45-degree field of view.
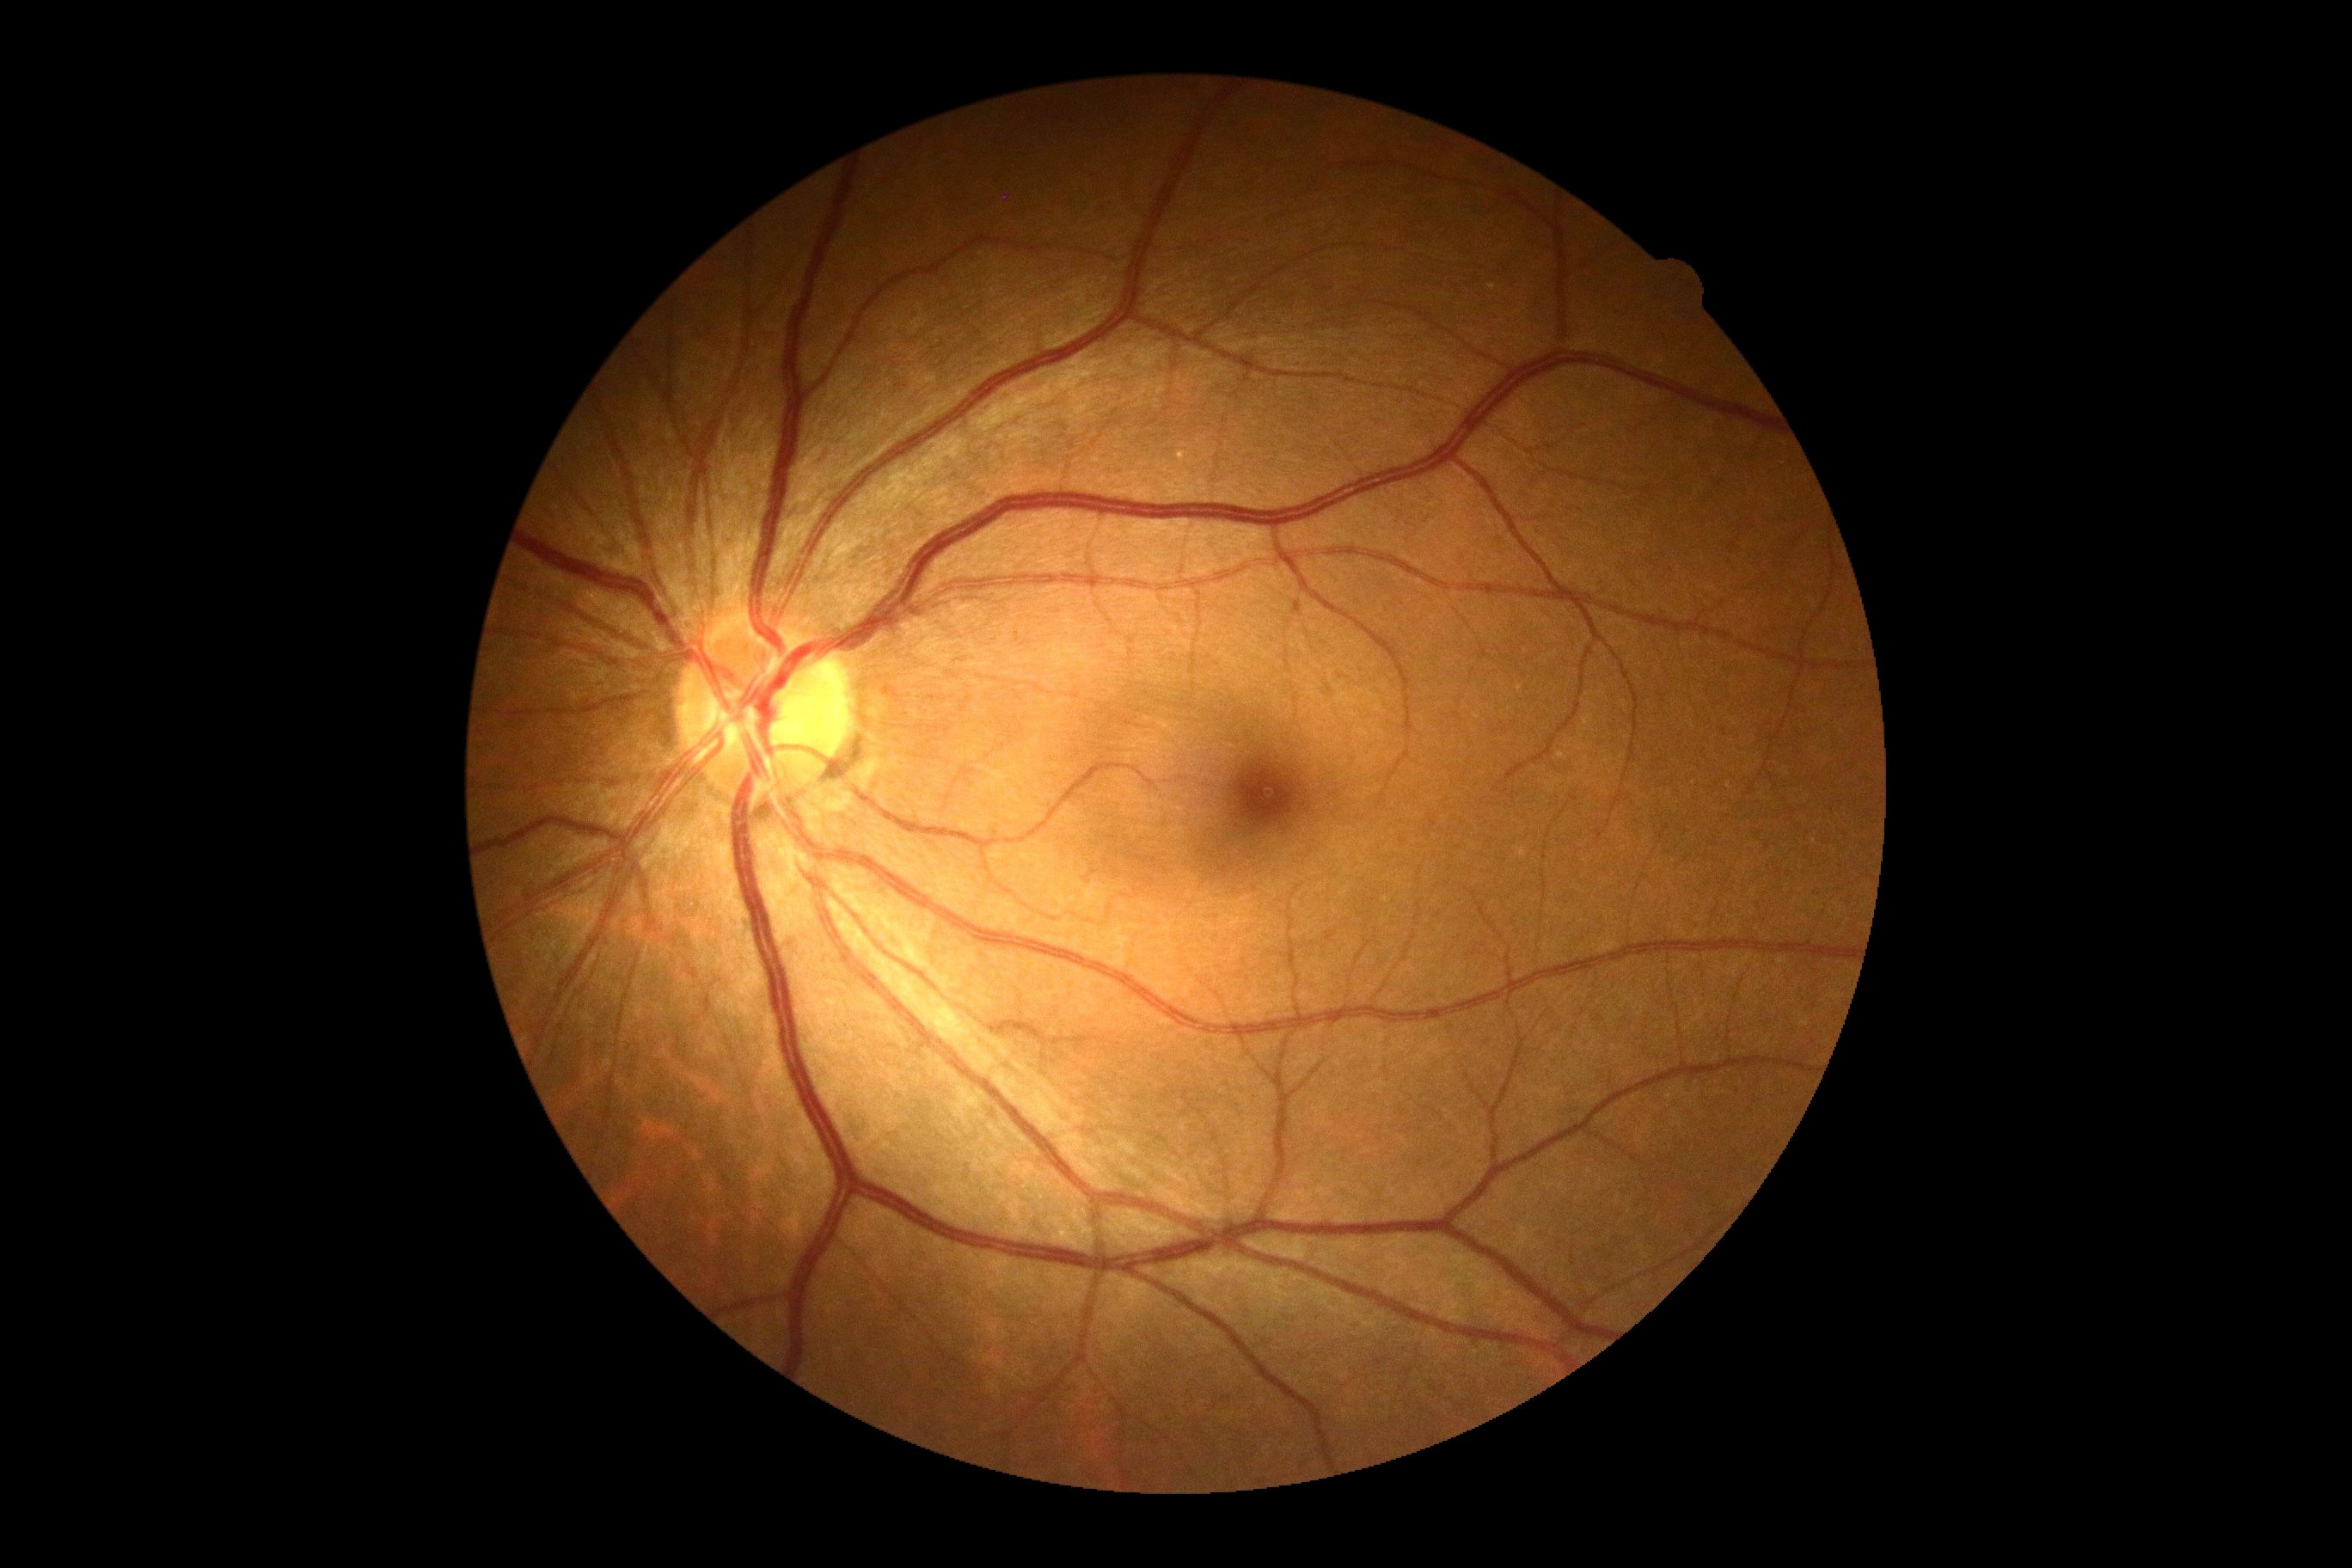

Diabetic retinopathy (DR): grade 0.